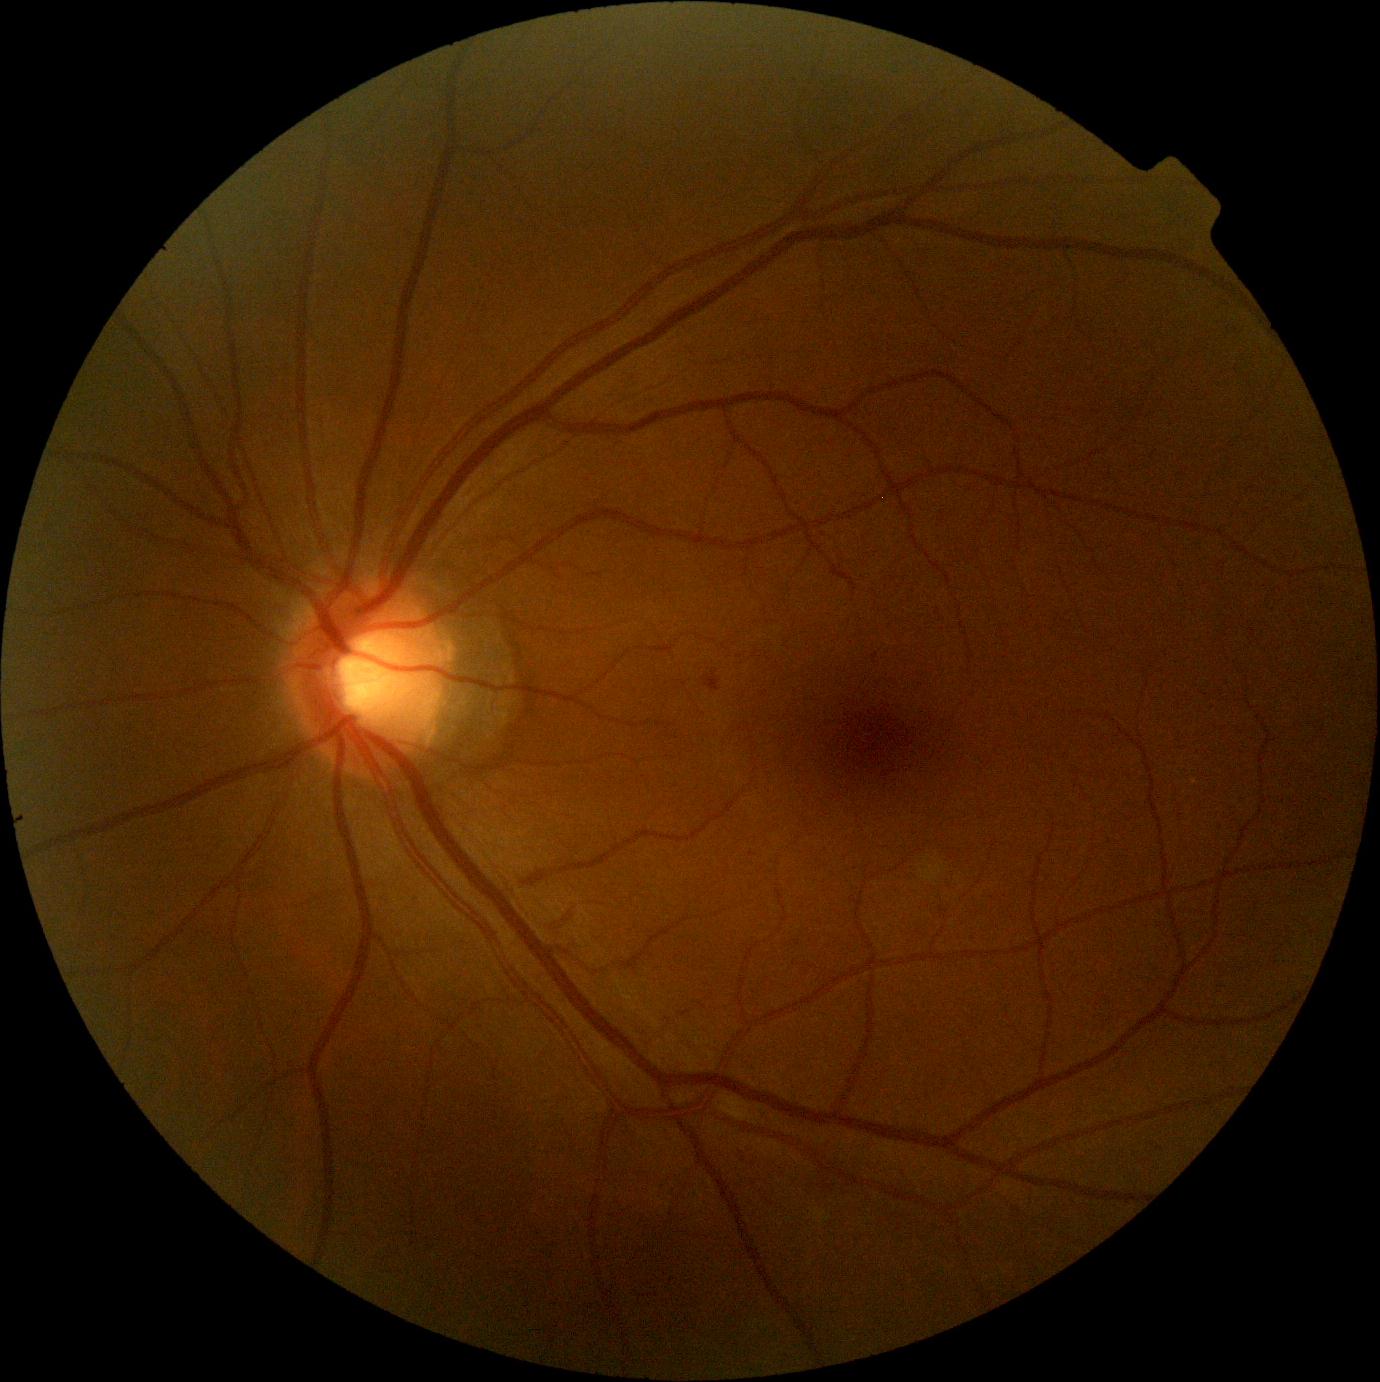
DR grade is 2 (moderate NPDR).